Wide-field fundus image from infant ROP screening; Phoenix ICON, 100° FOV:
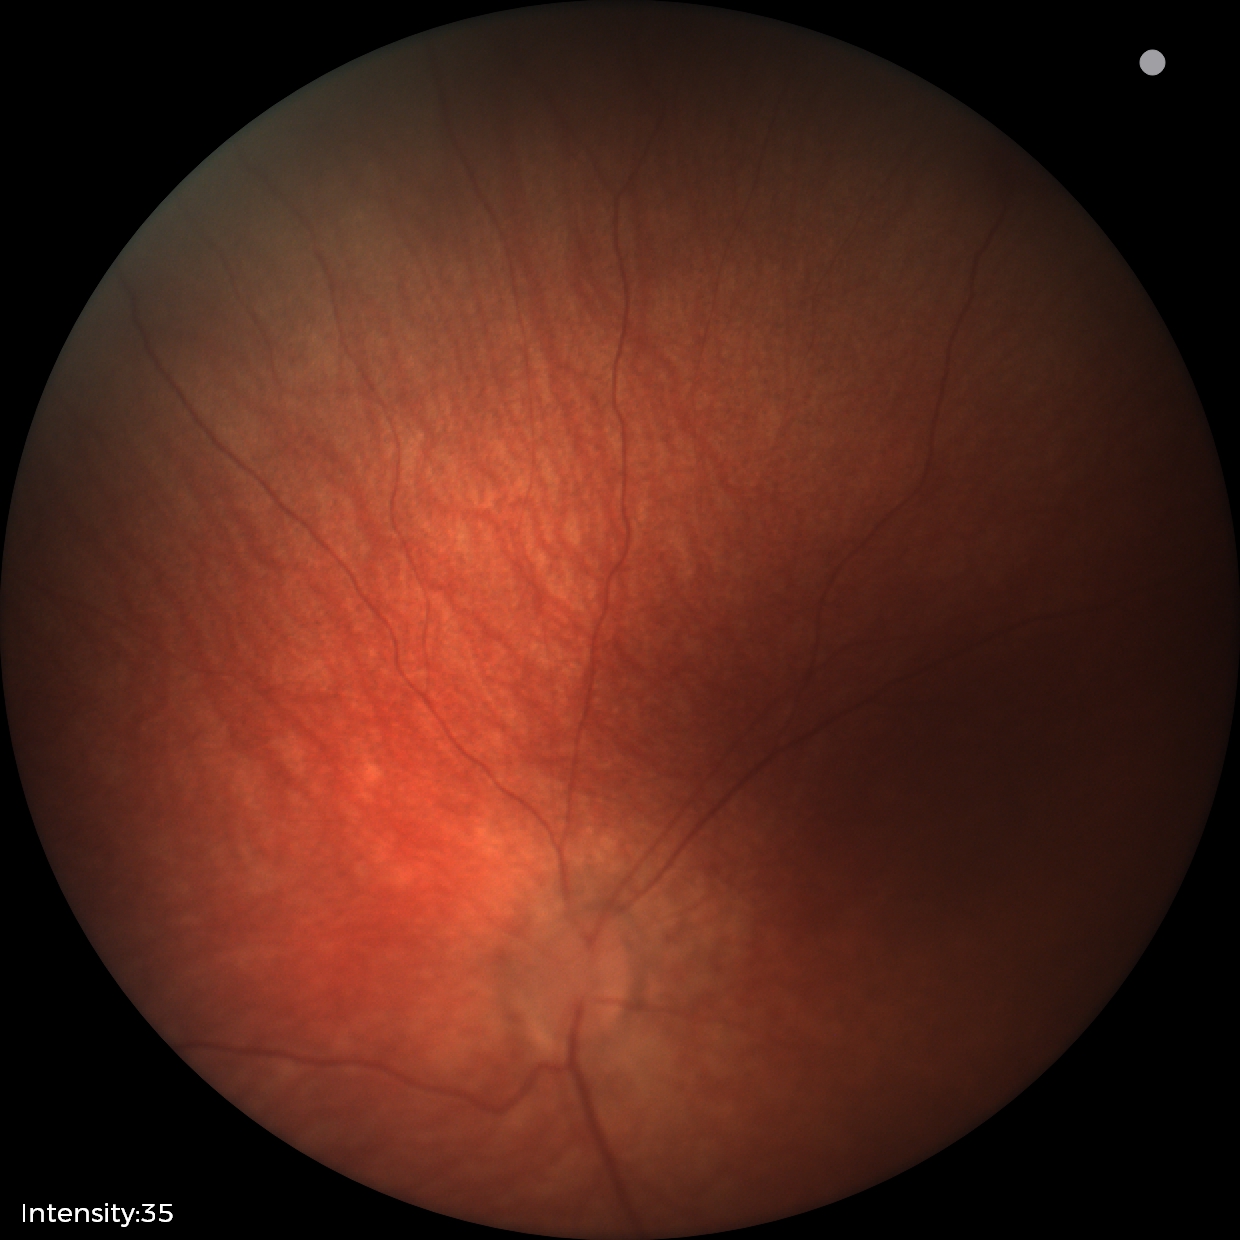
Screening examination diagnosed as physiological.